45-degree field of view; retinal fundus photograph
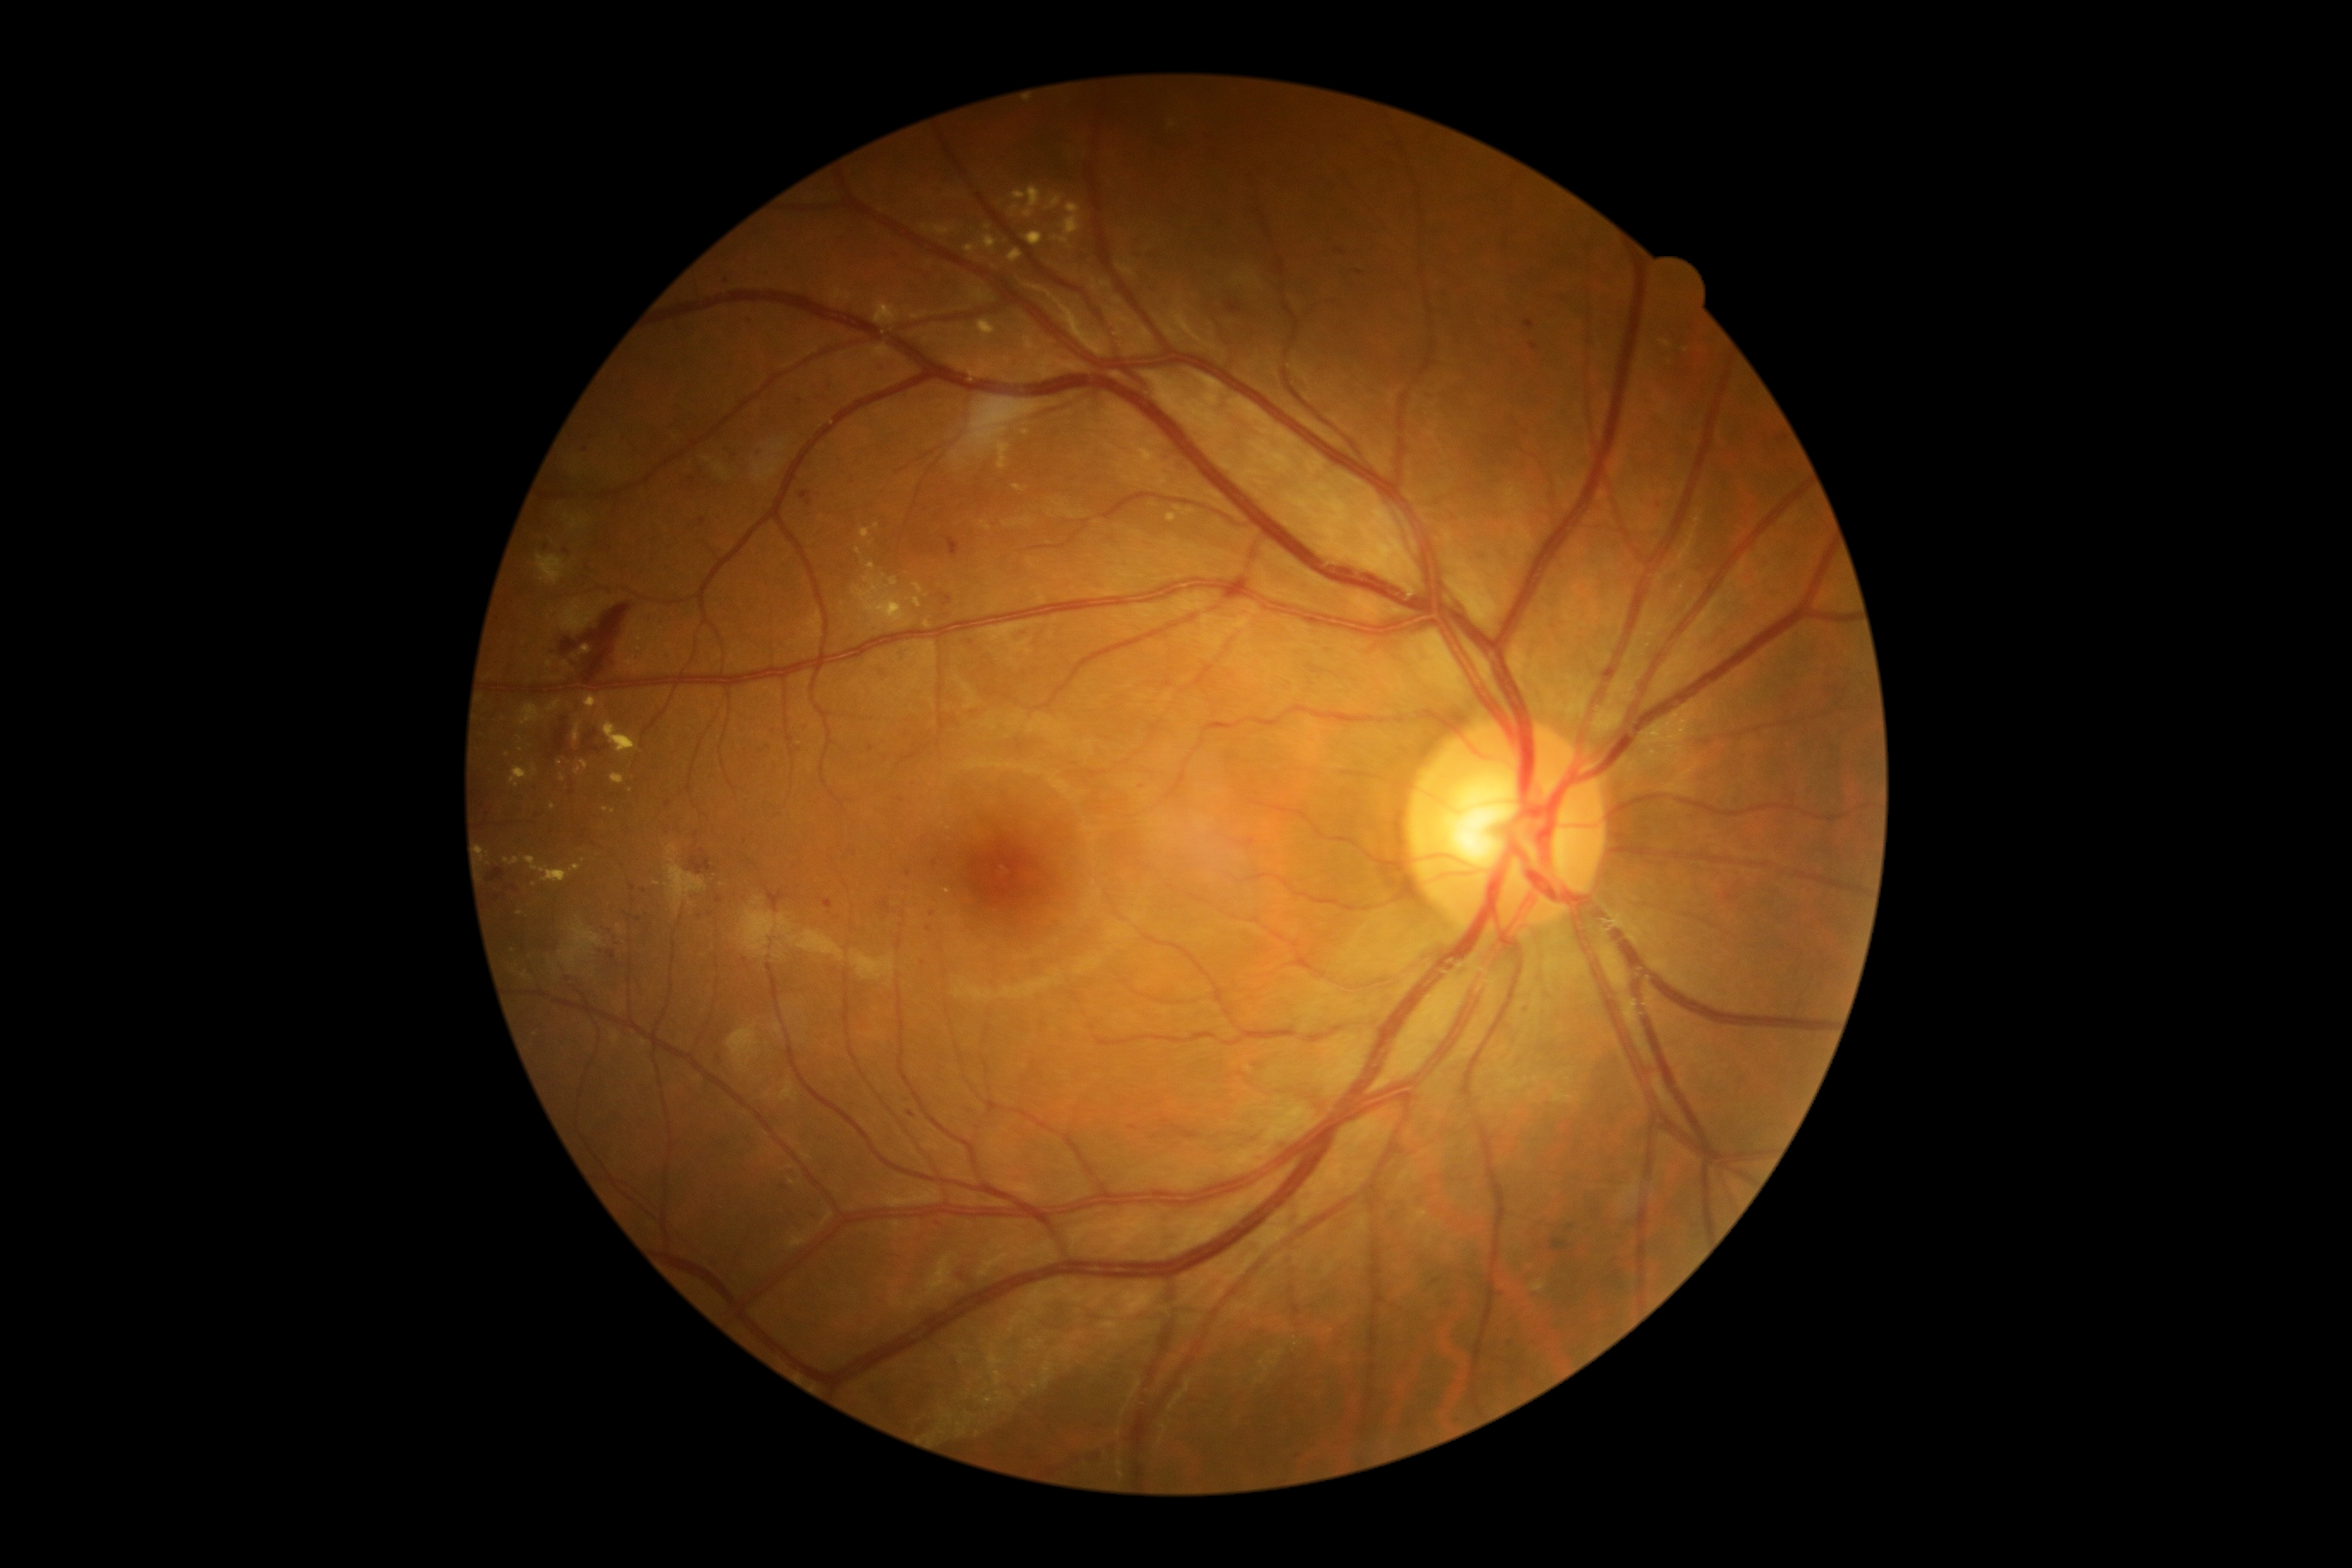
partial: true
dr_grade: 2
lesions:
  ma:
    - Rect(943, 596, 953, 606)
    - Rect(1643, 1069, 1651, 1077)
    - Rect(823, 900, 835, 909)
    - Rect(608, 952, 616, 960)
    - Rect(867, 745, 874, 754)
  ma_small:
    - 908/874
    - 692/480
    - 668/804
    - 572/792
    - 702/521
    - 1360/273
    - 936/864
    - 907/734
    - 922/964
    - 929/930
    - 972/642
    - 938/1225
    - 697/834
  ex:
    - Rect(914, 599, 922, 608)
    - Rect(537, 554, 567, 585)
    - Rect(1529, 1282, 1547, 1292)
    - Rect(1046, 195, 1063, 211)
    - Rect(532, 766, 537, 778)
    - Rect(1008, 248, 1024, 262)
    - Rect(874, 302, 900, 324)
    - Rect(977, 321, 998, 338)
    - Rect(525, 855, 582, 883)
    - Rect(914, 584, 924, 594)
    - Rect(505, 857, 520, 866)
  ex_small:
    - 871/543
    - 560/763
    - 534/884
    - 927/625